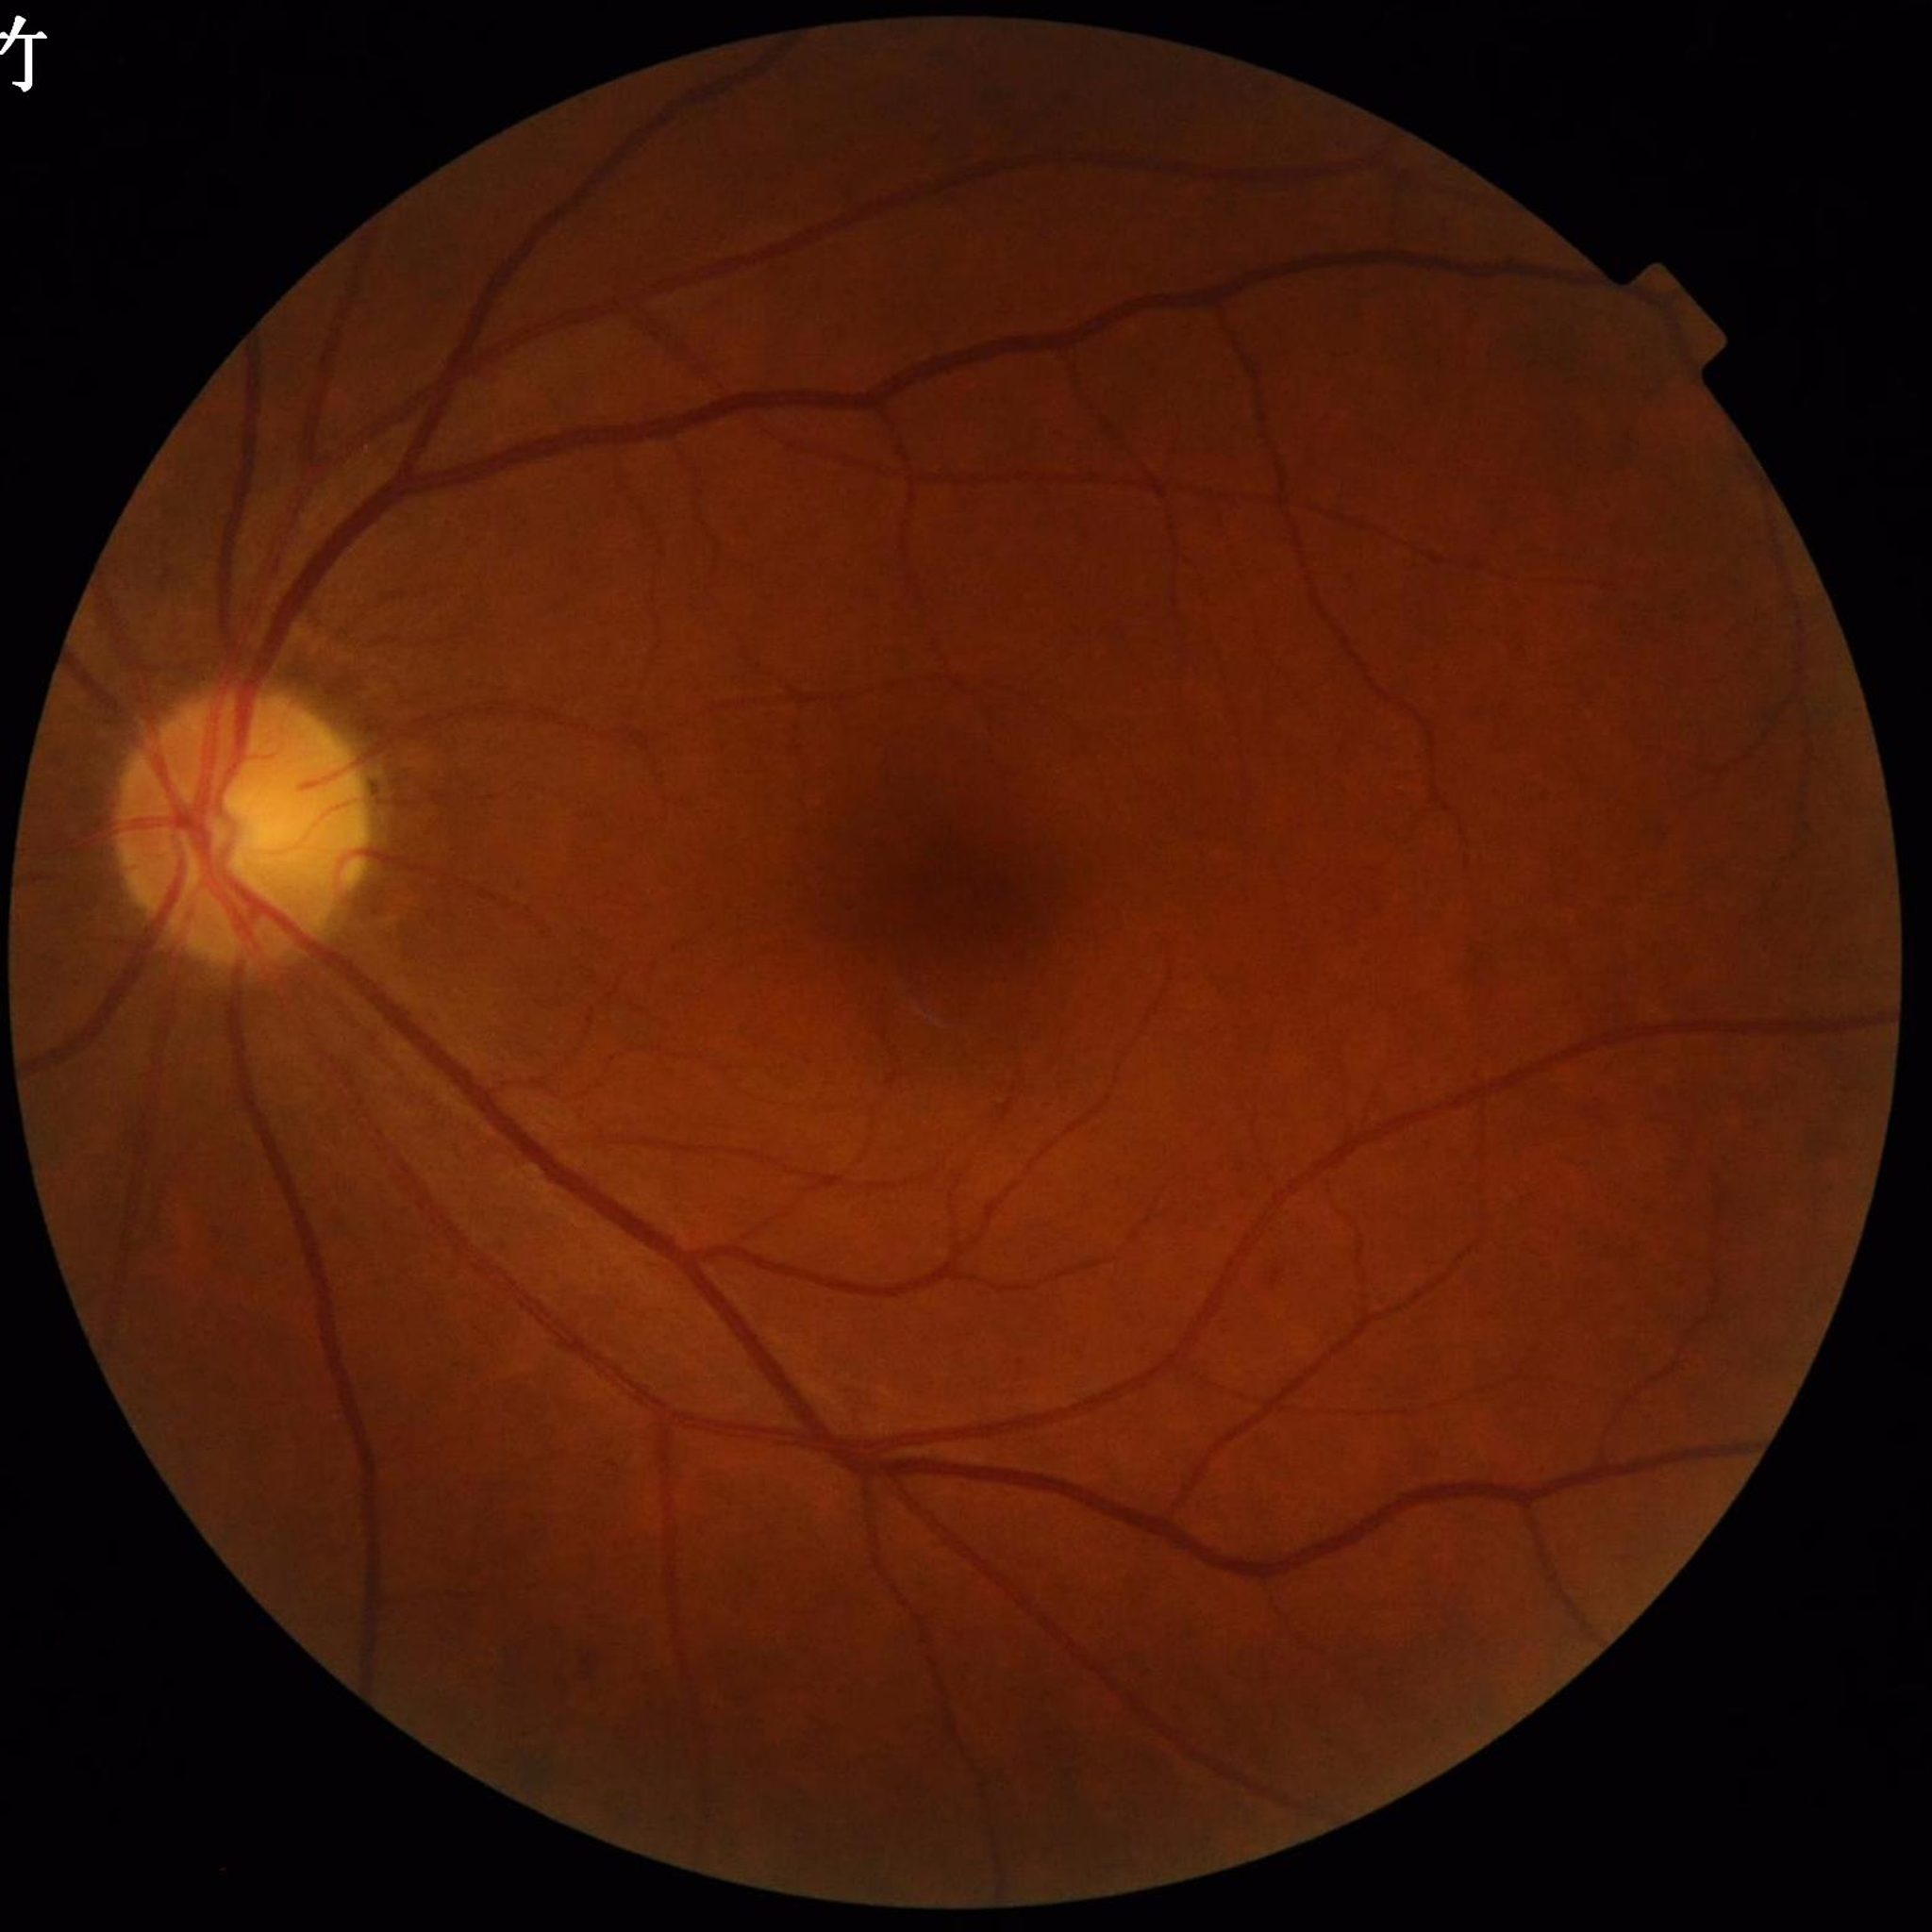 This fundus photograph is from a patient diagnosed with DR. Image quality: no quality issues identified.